RetCam wide-field infant fundus image. Camera: Natus RetCam Envision (130° FOV): 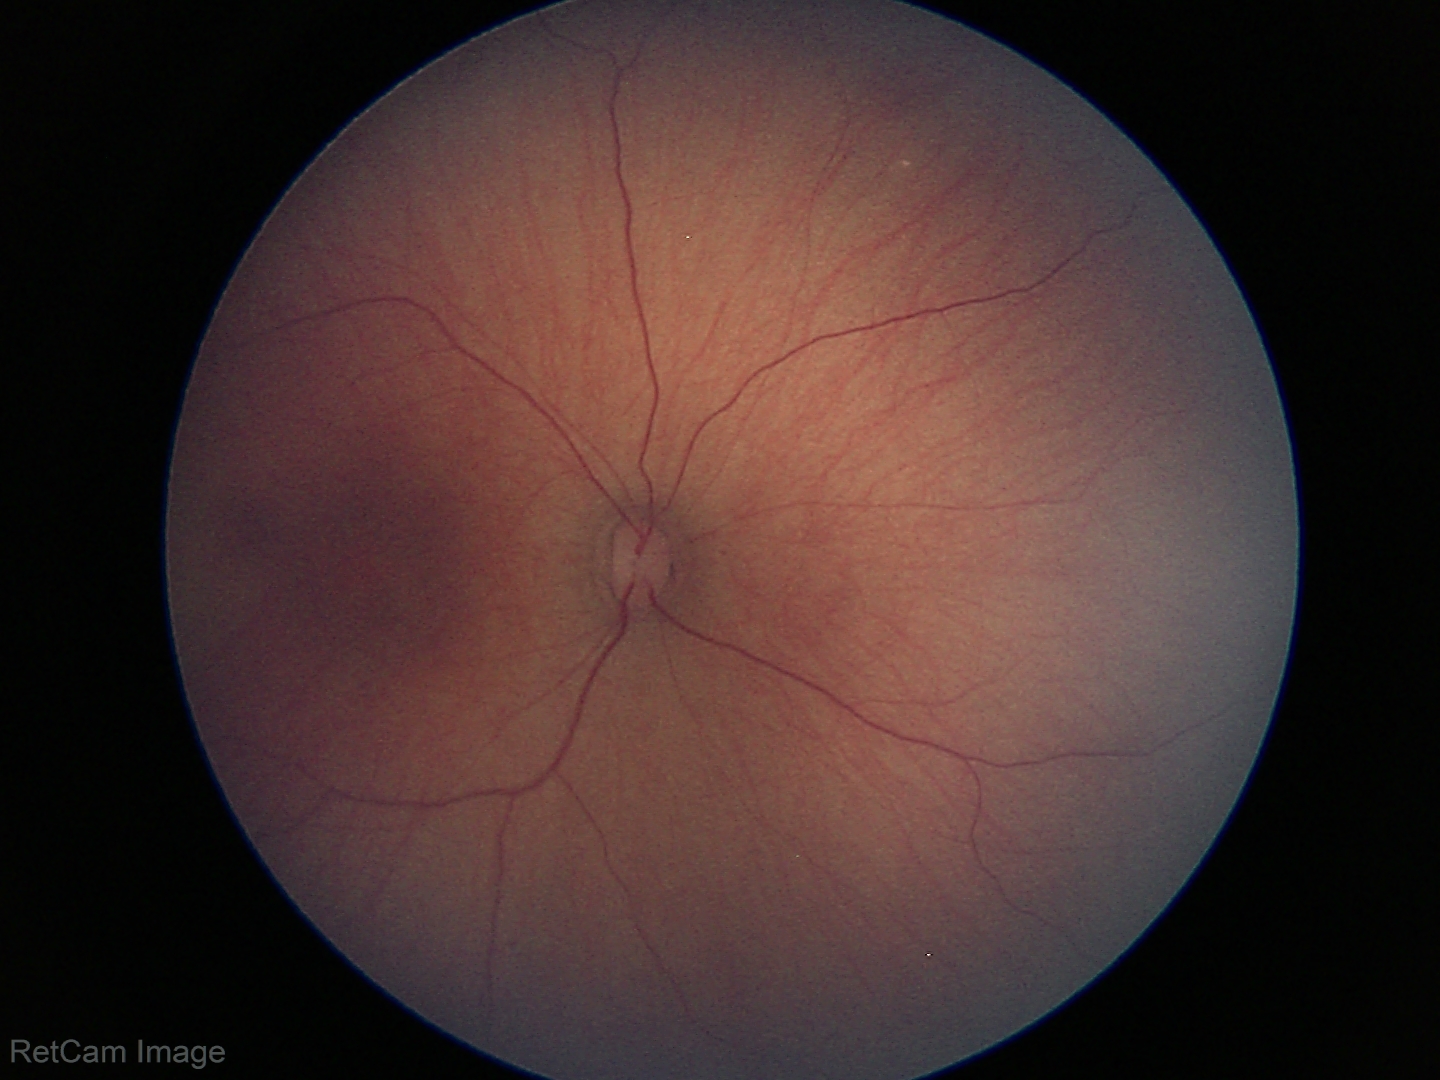

Screening: physiological retinal finding.